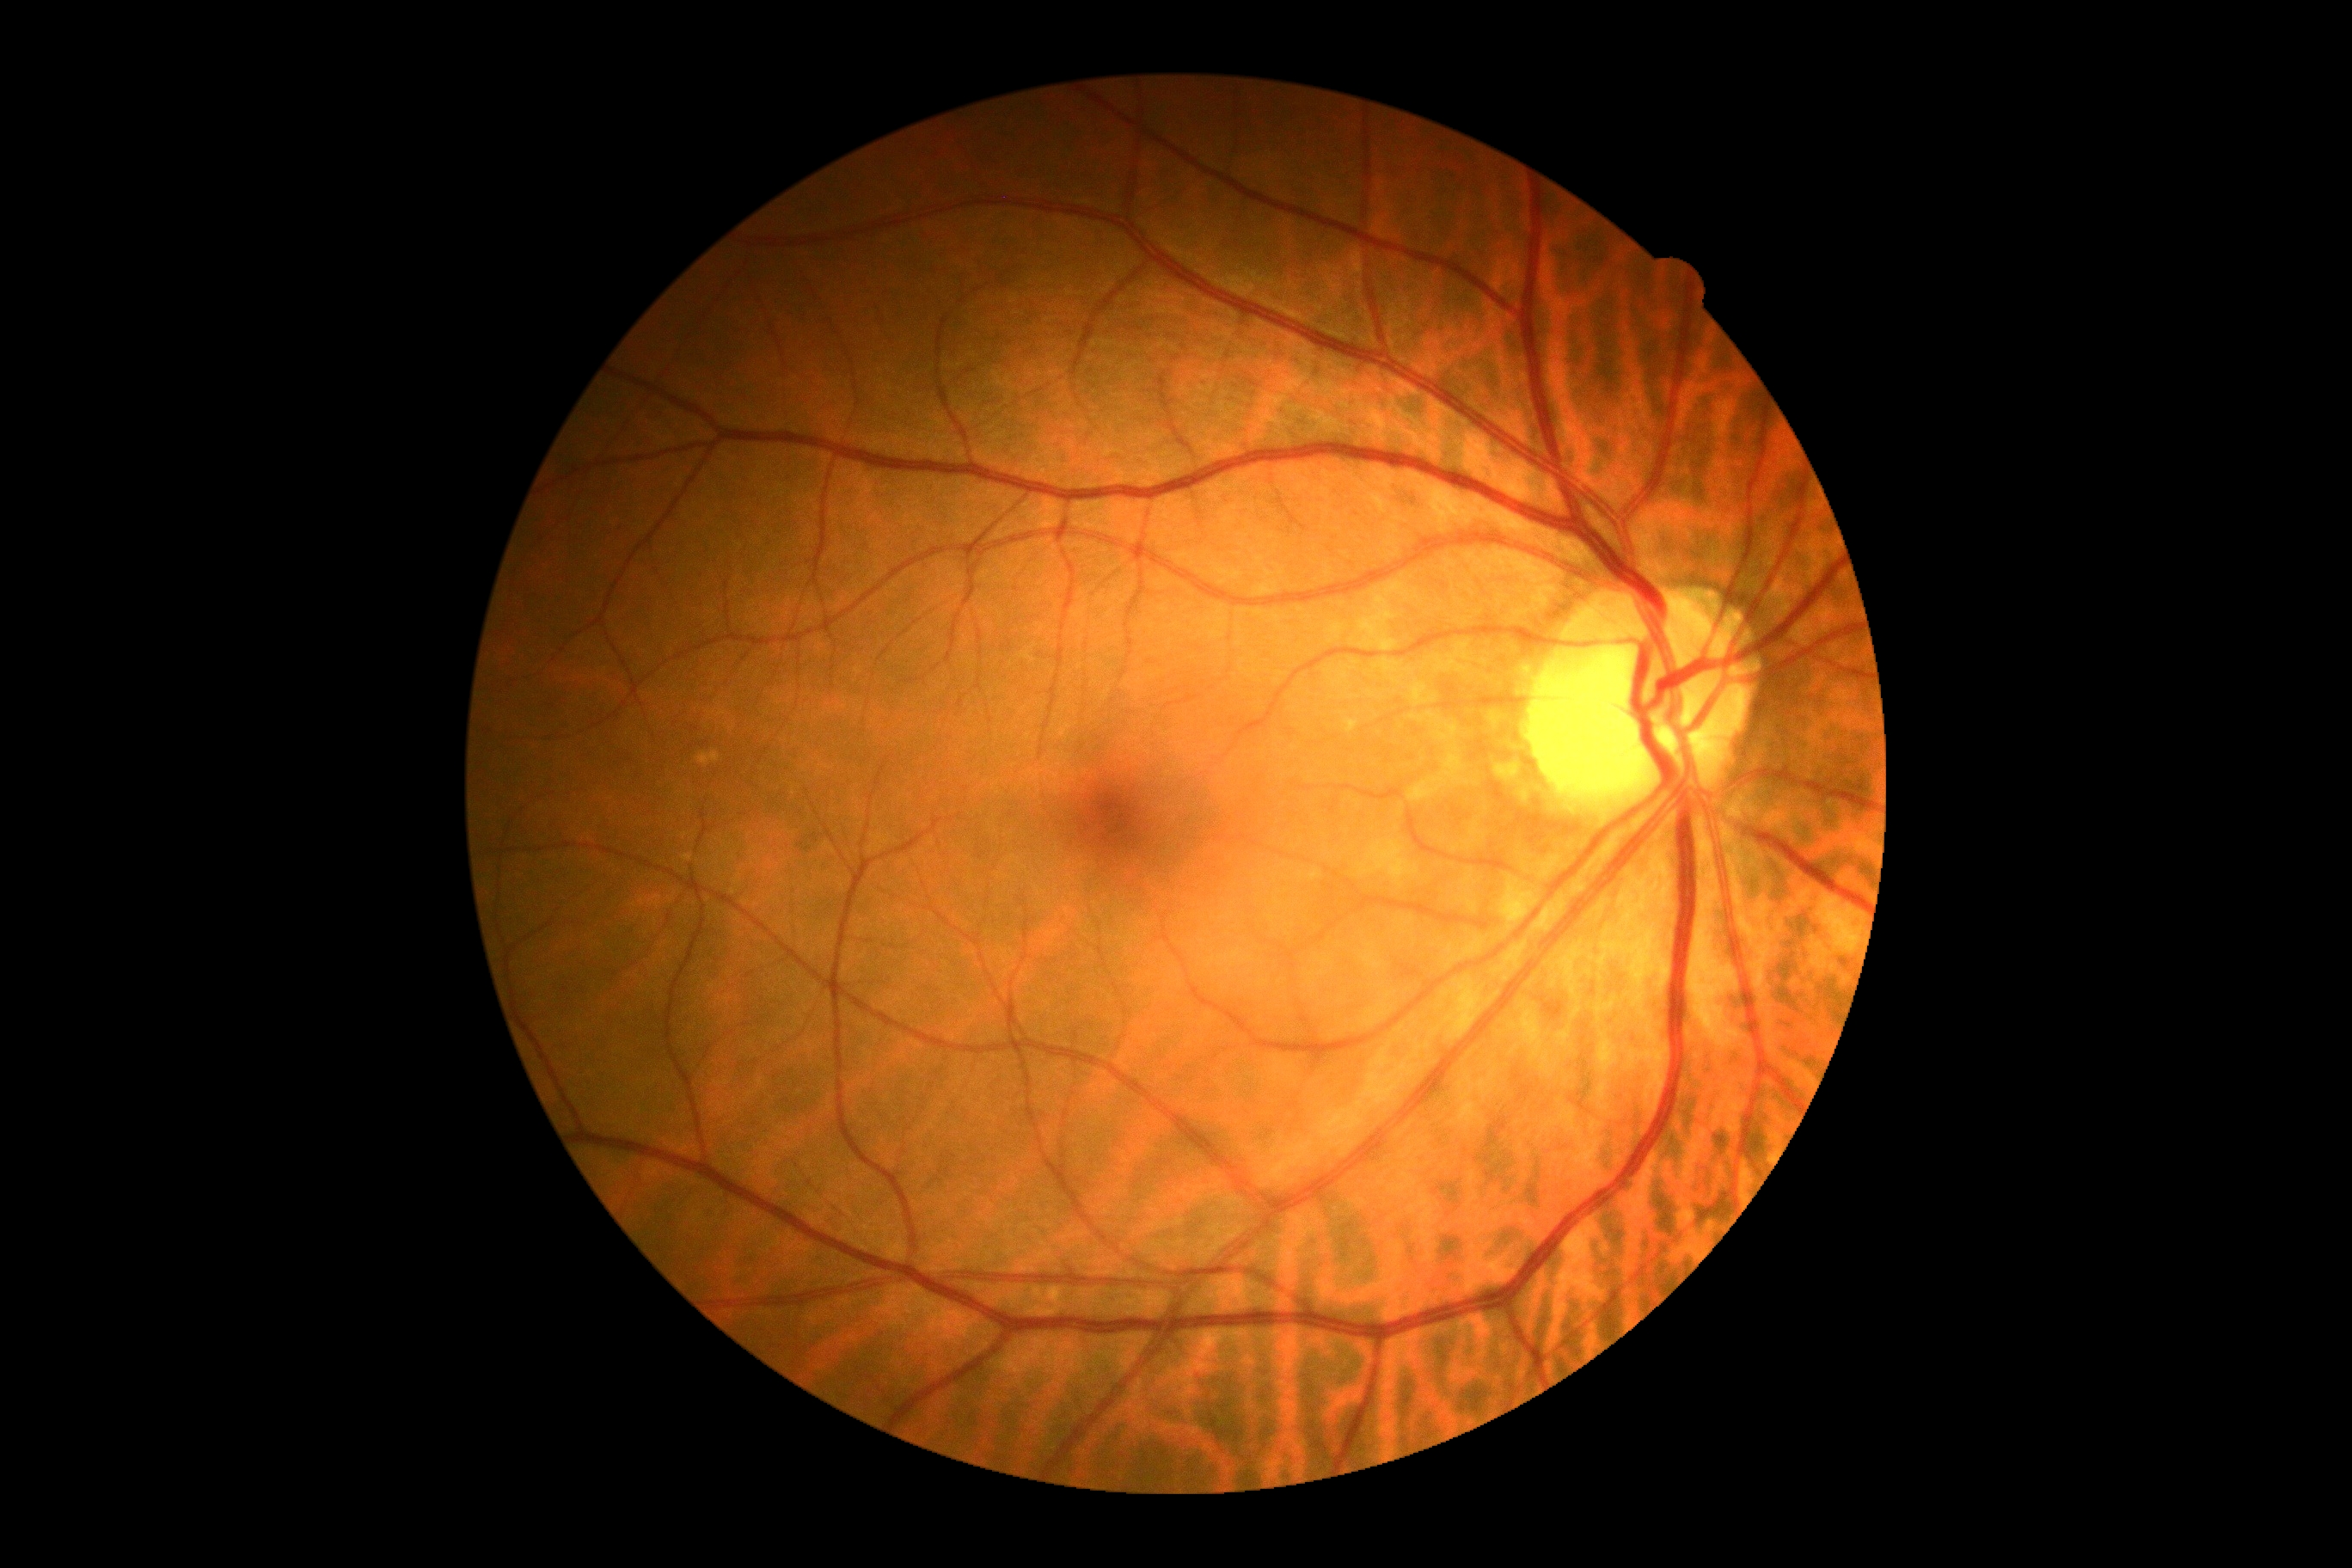

Diabetic retinopathy severity: grade 0 (no apparent retinopathy) — no visible signs of diabetic retinopathy.